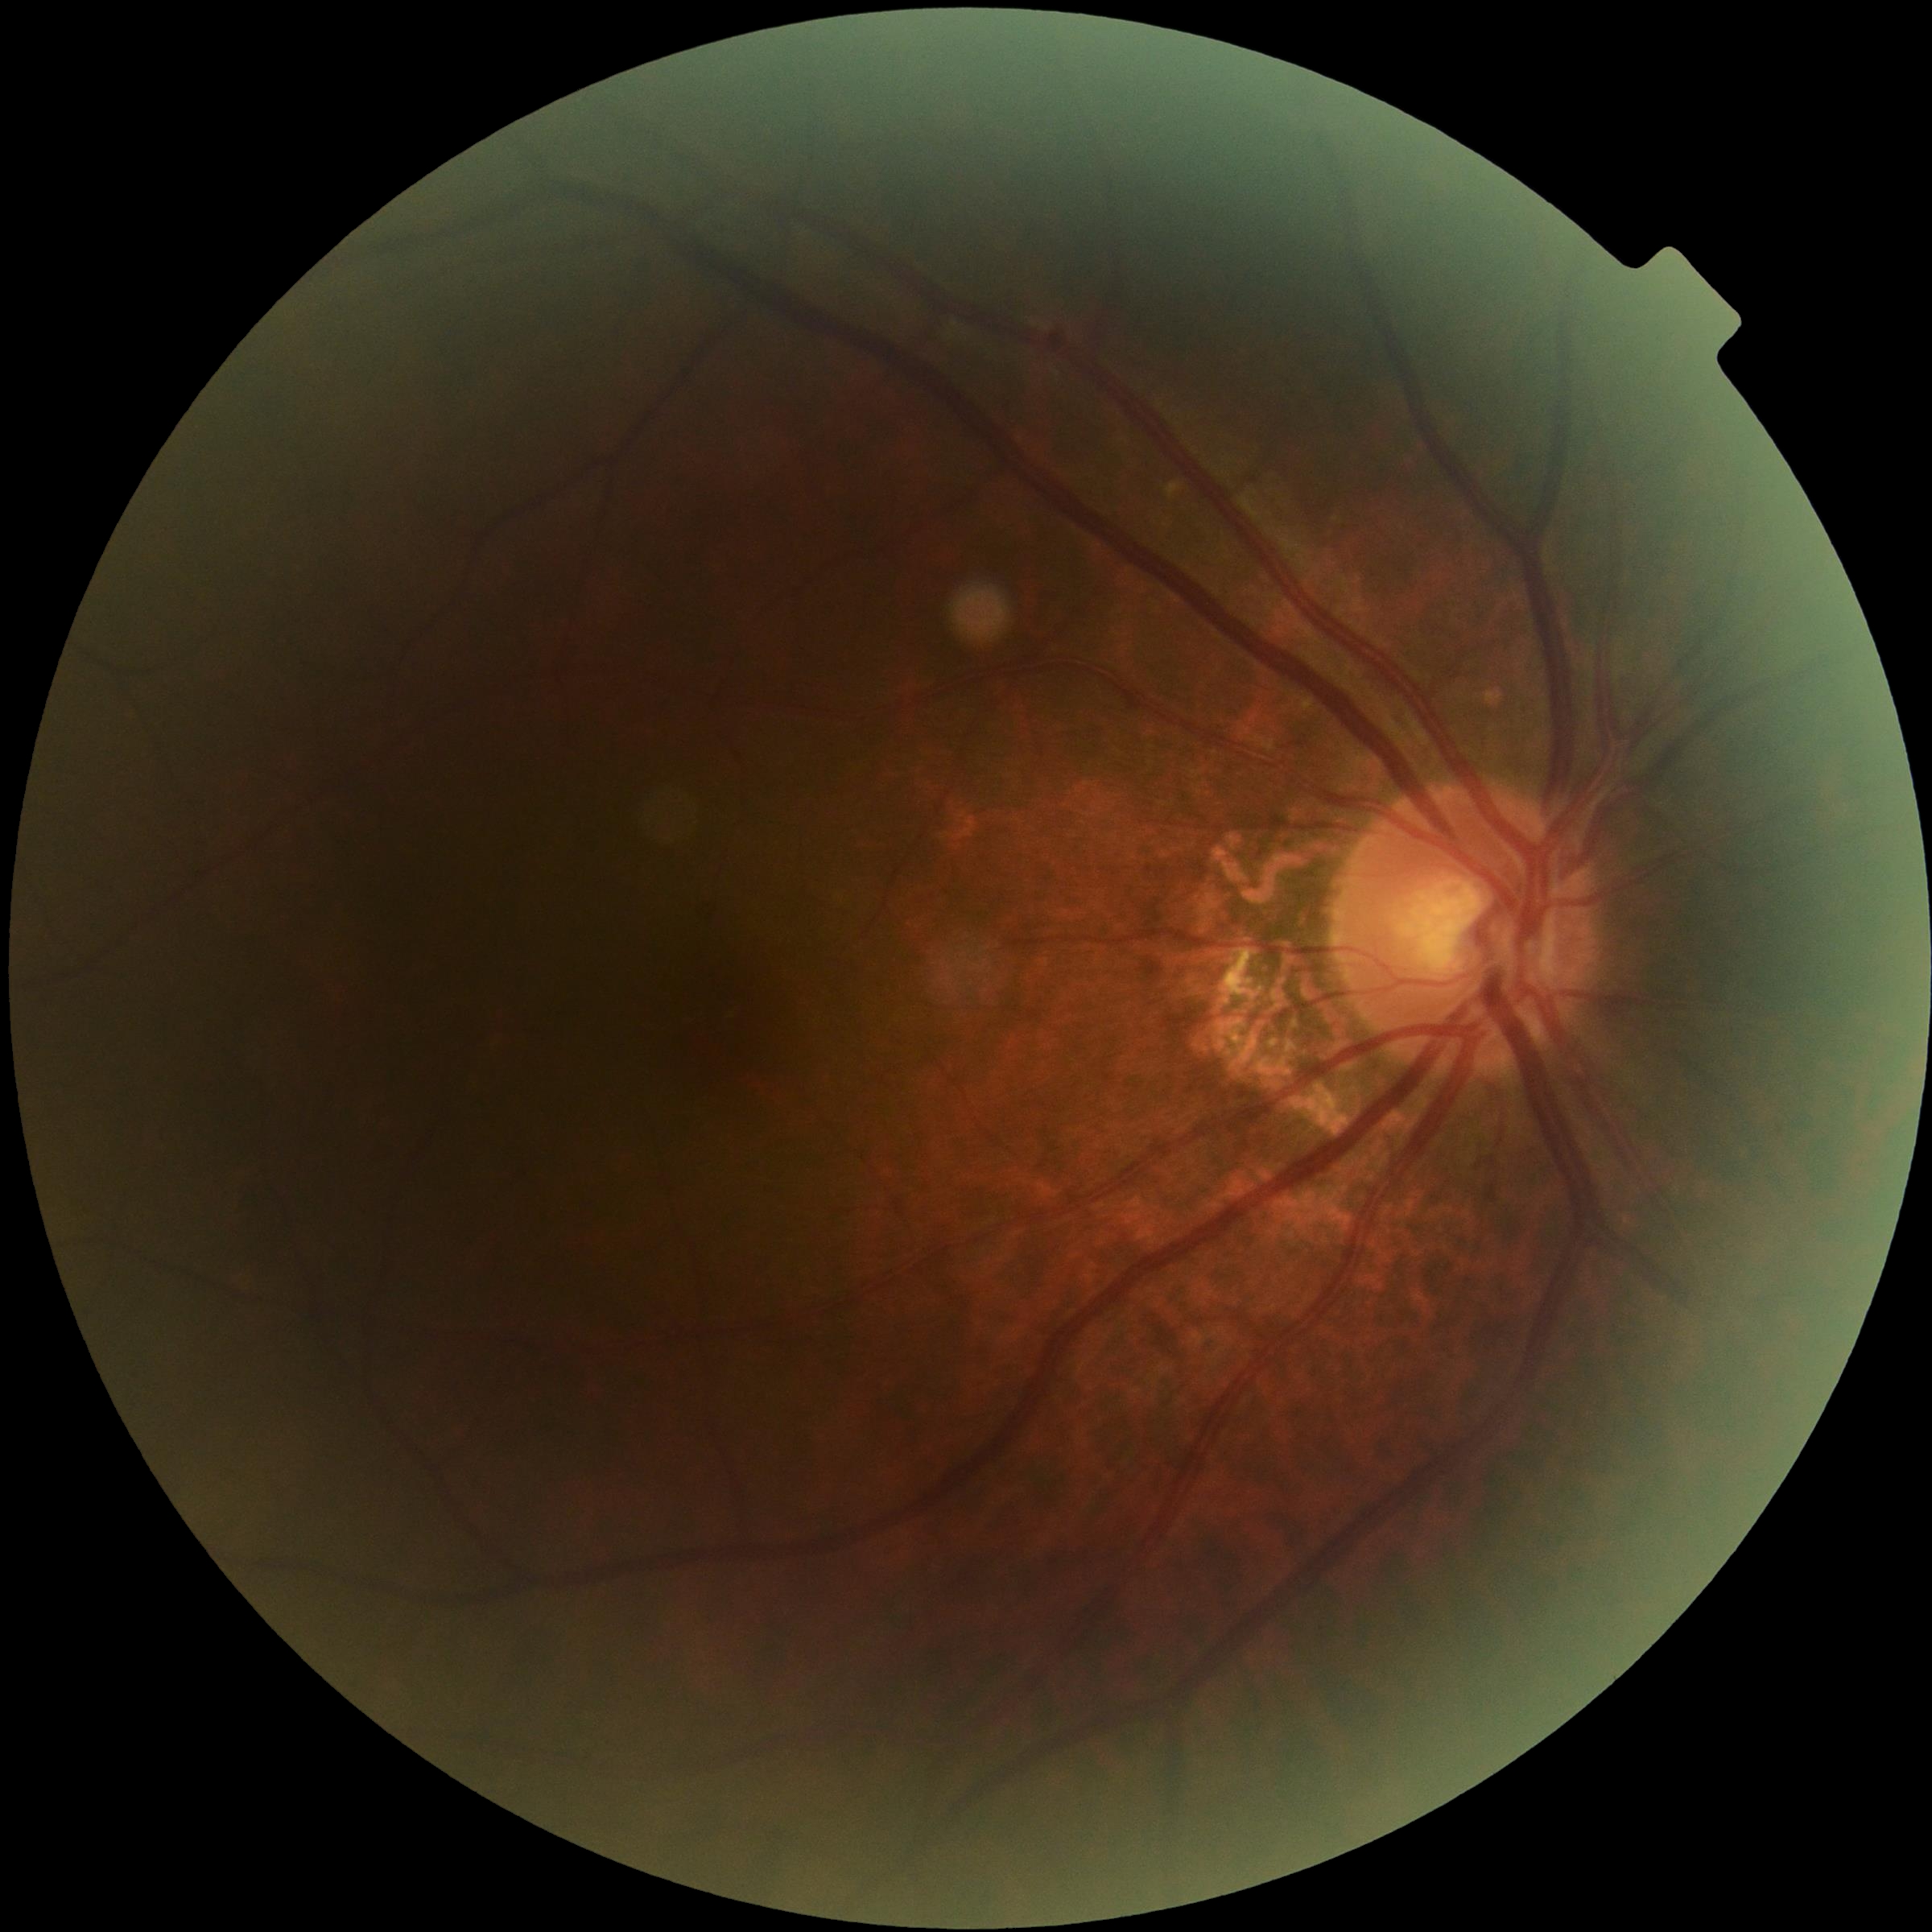

  dr_grade: grade 0 (no apparent retinopathy)